45-degree field of view
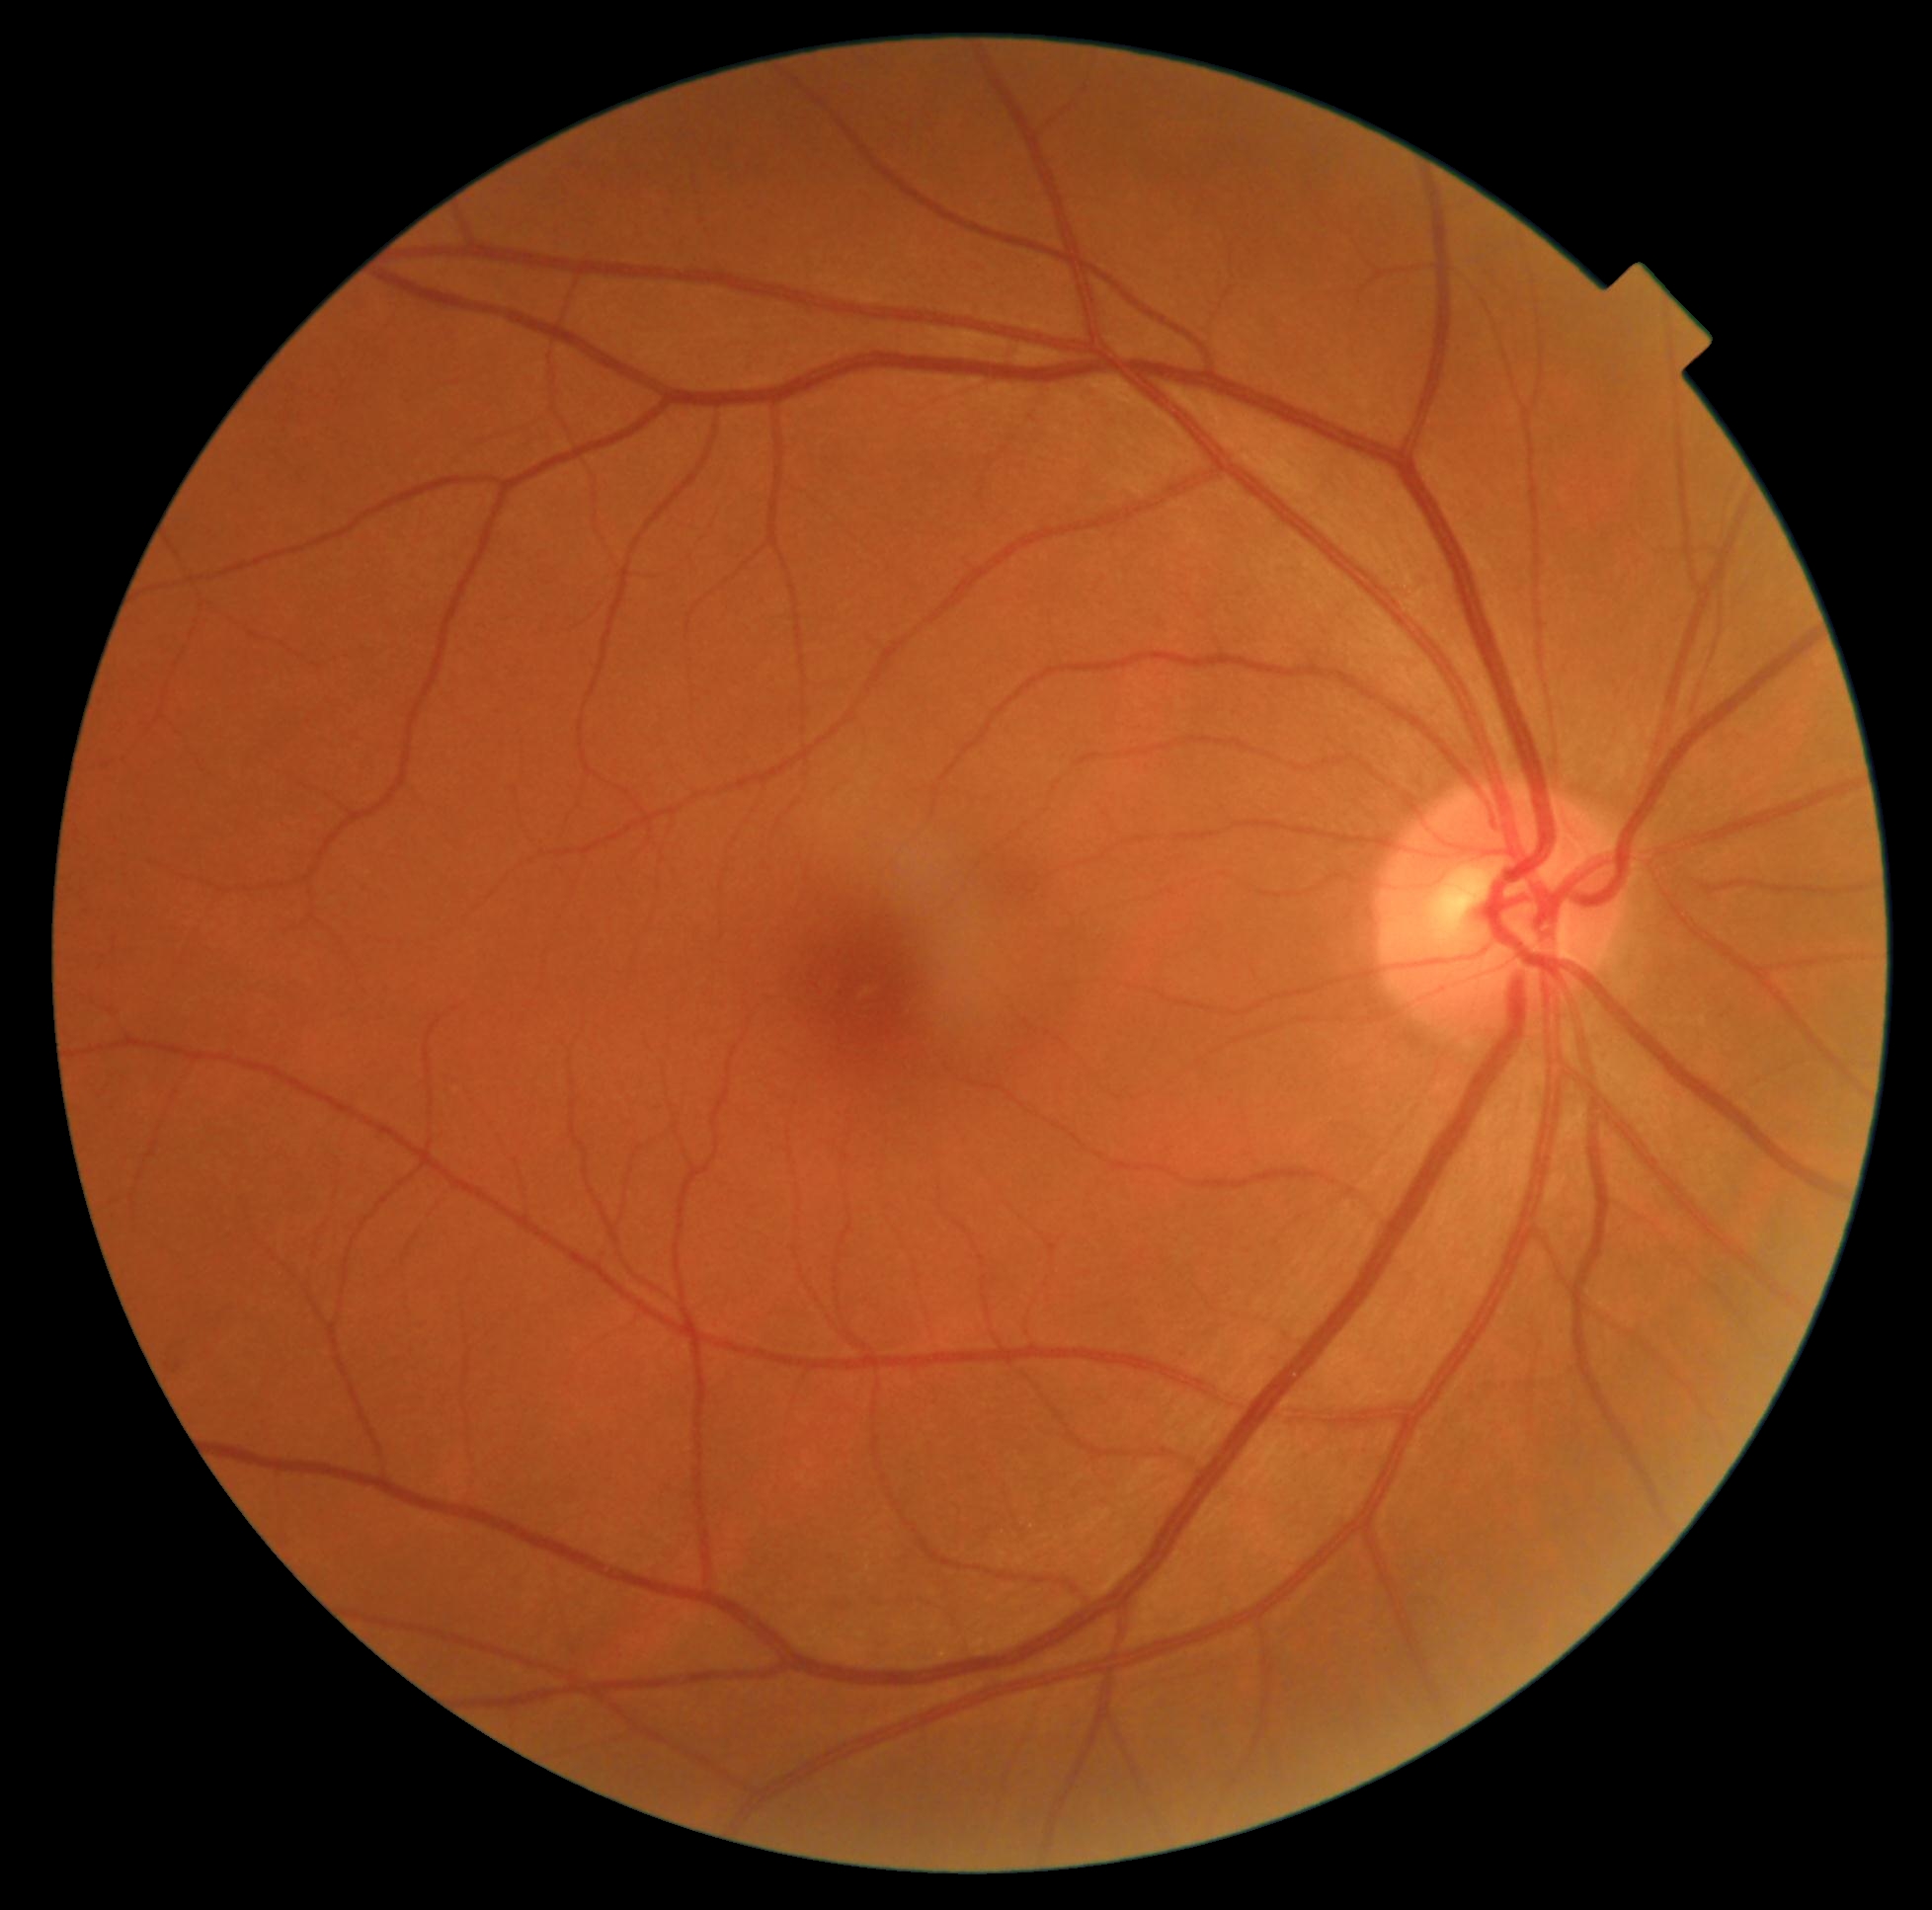
No diabetic retinal disease findings. DR: grade 0 (no apparent retinopathy) — no visible signs of diabetic retinopathy.